2048 by 1536 pixels: 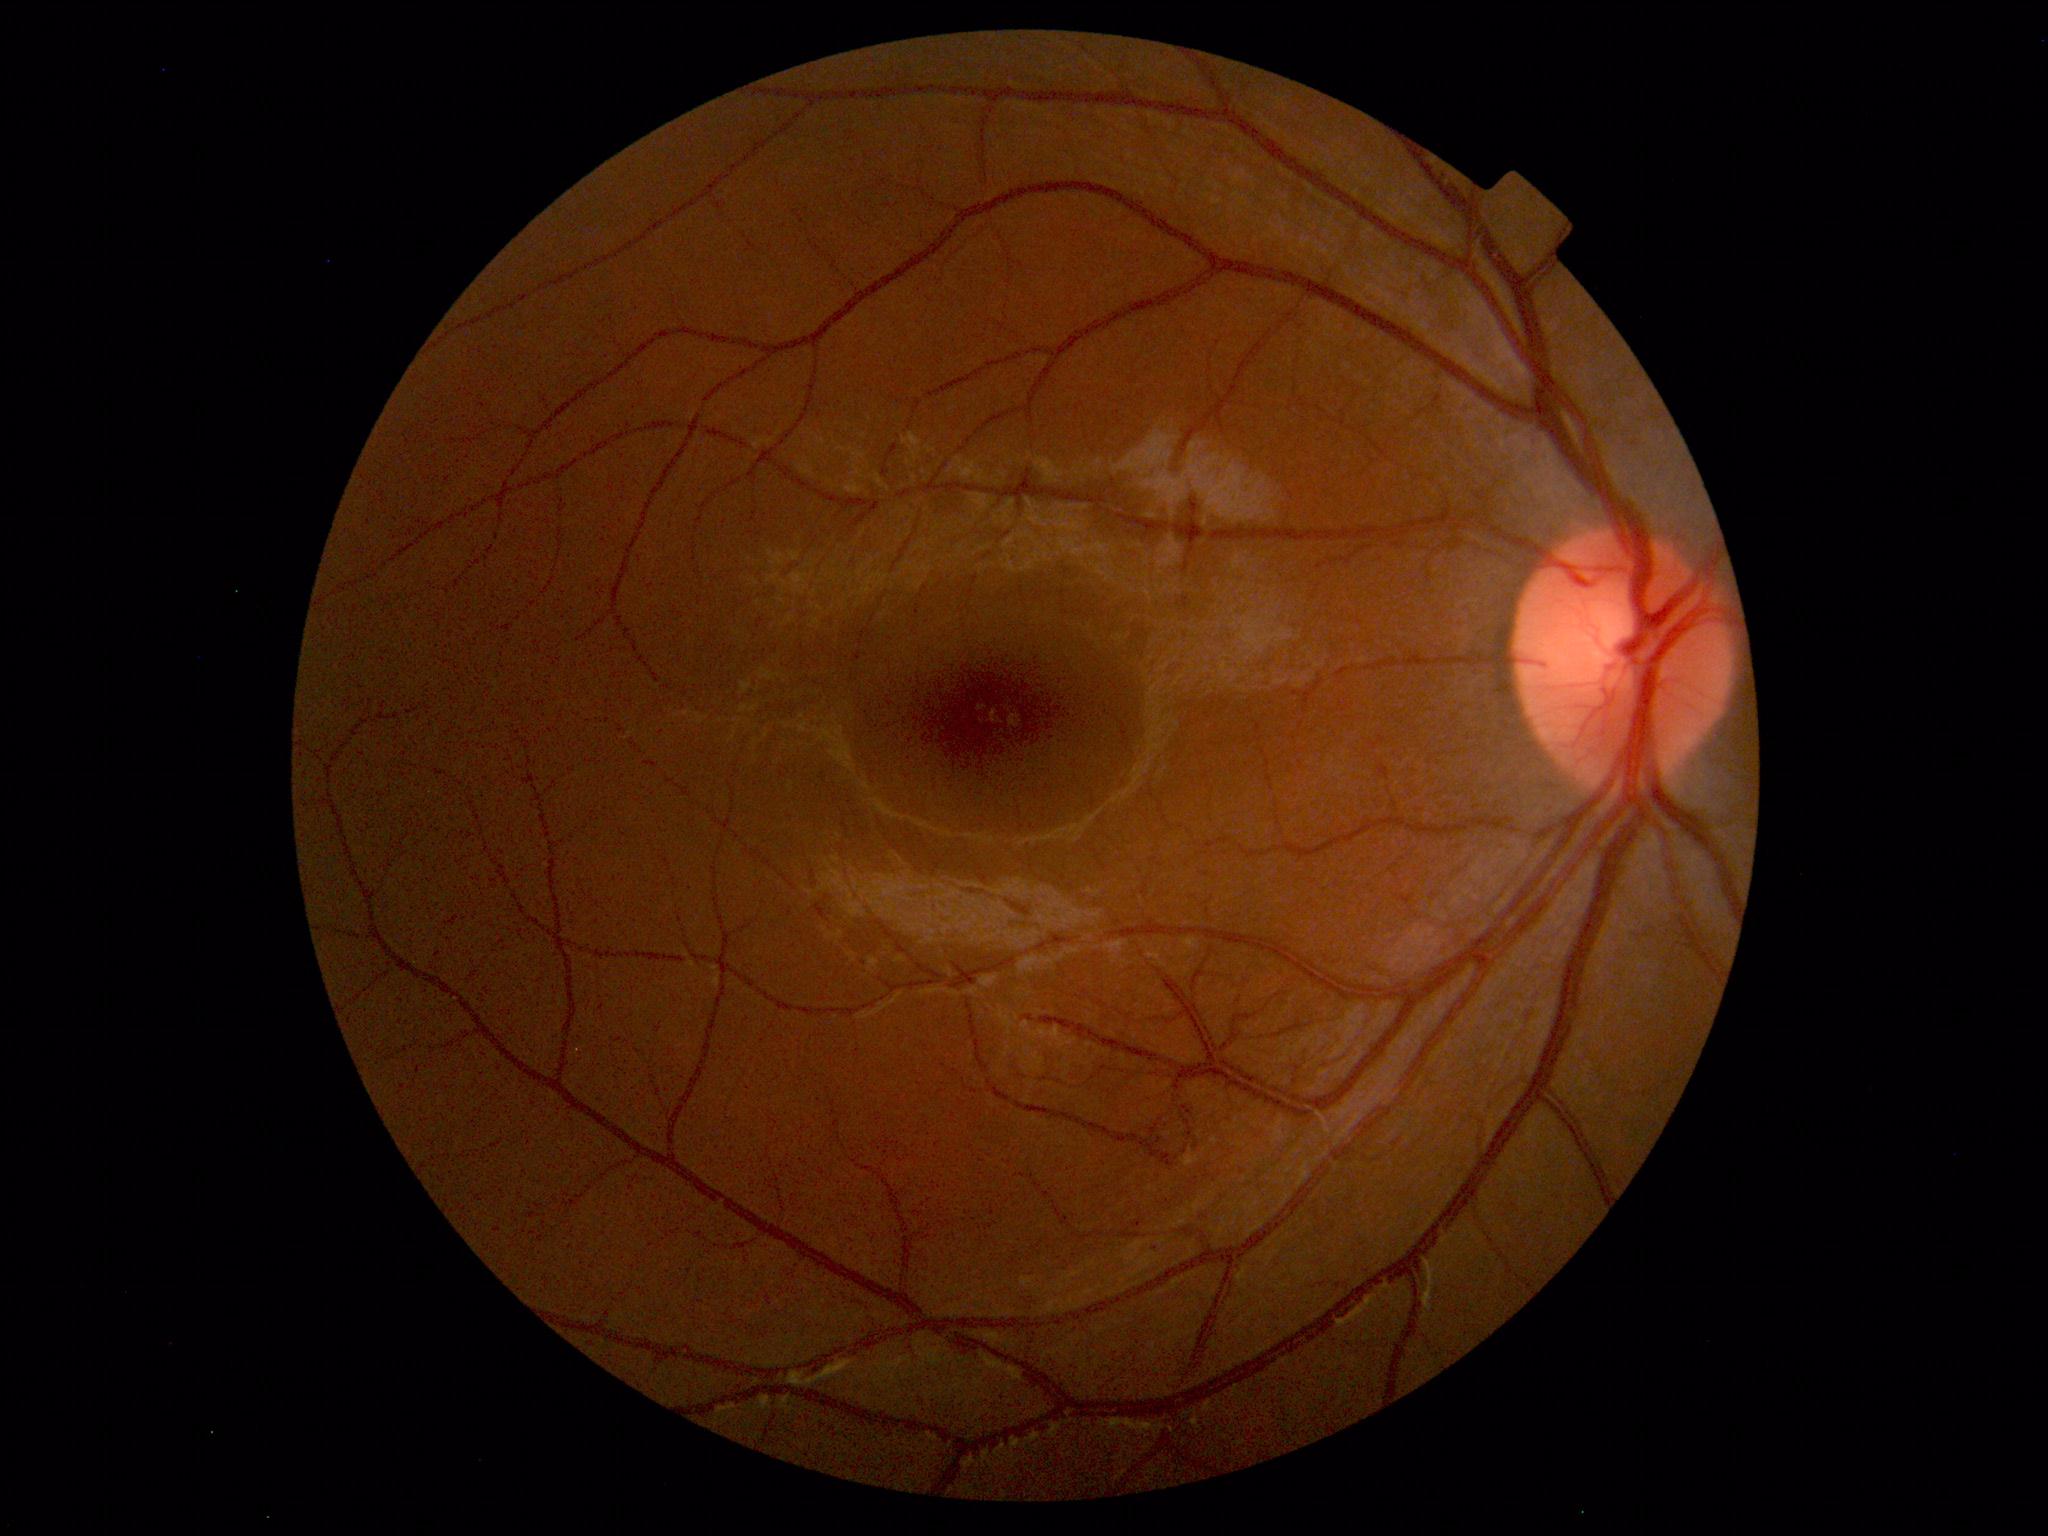
Normal retinal fundus image with no abnormalities identified.